2212x1659px; retinal fundus photograph: 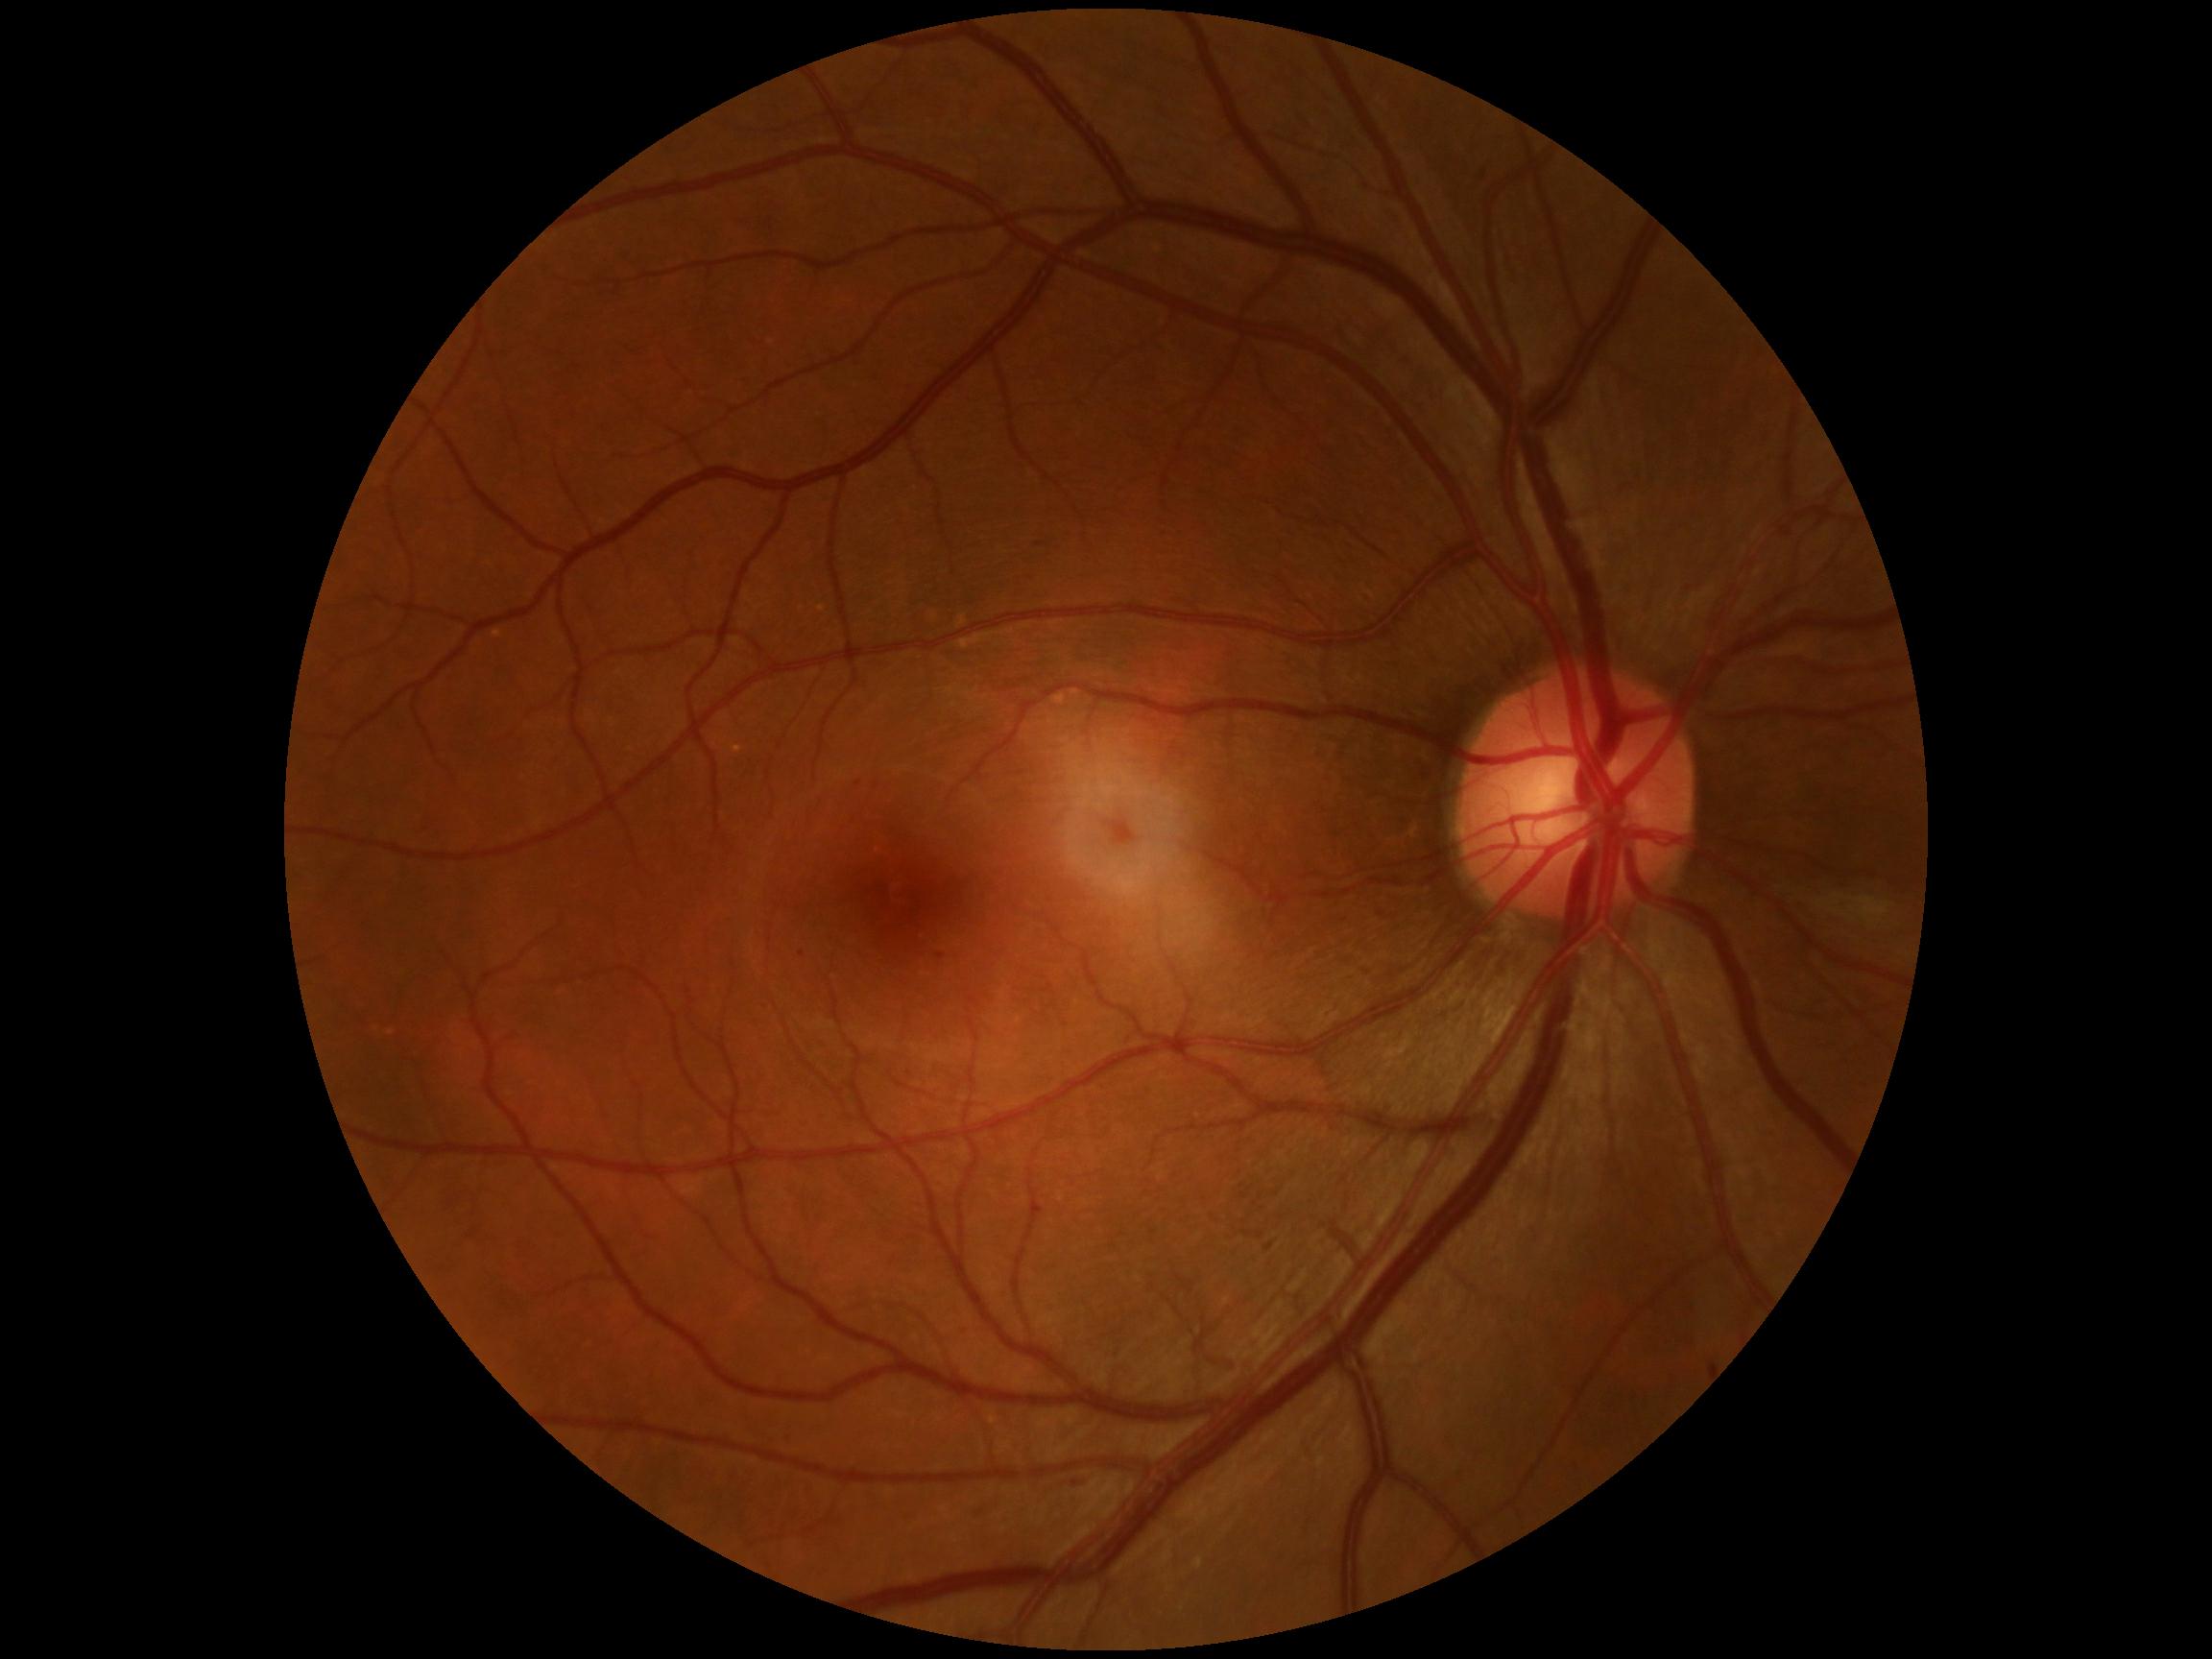

DR severity: grade 1 (mild NPDR).